NIDEK AFC-230 fundus camera; image size 848x848; without pupil dilation:
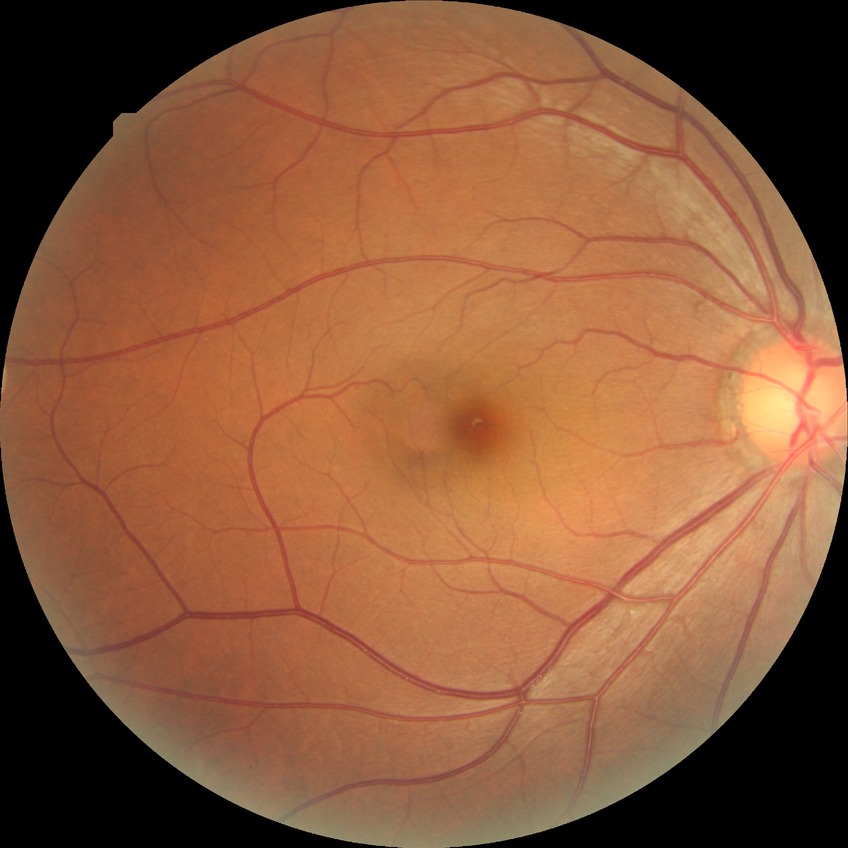

  davis_grade: no diabetic retinopathy